CFP: 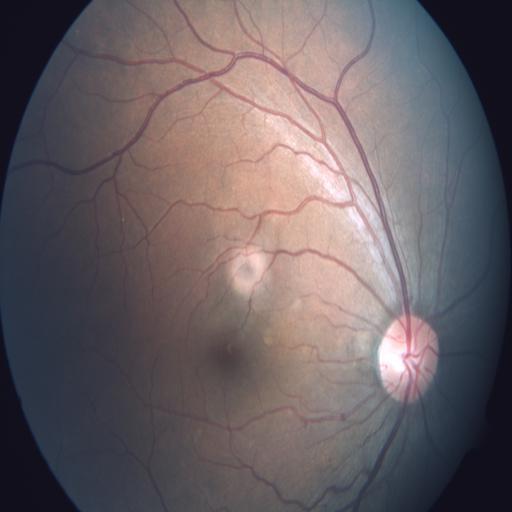
Normal fundus appearance.